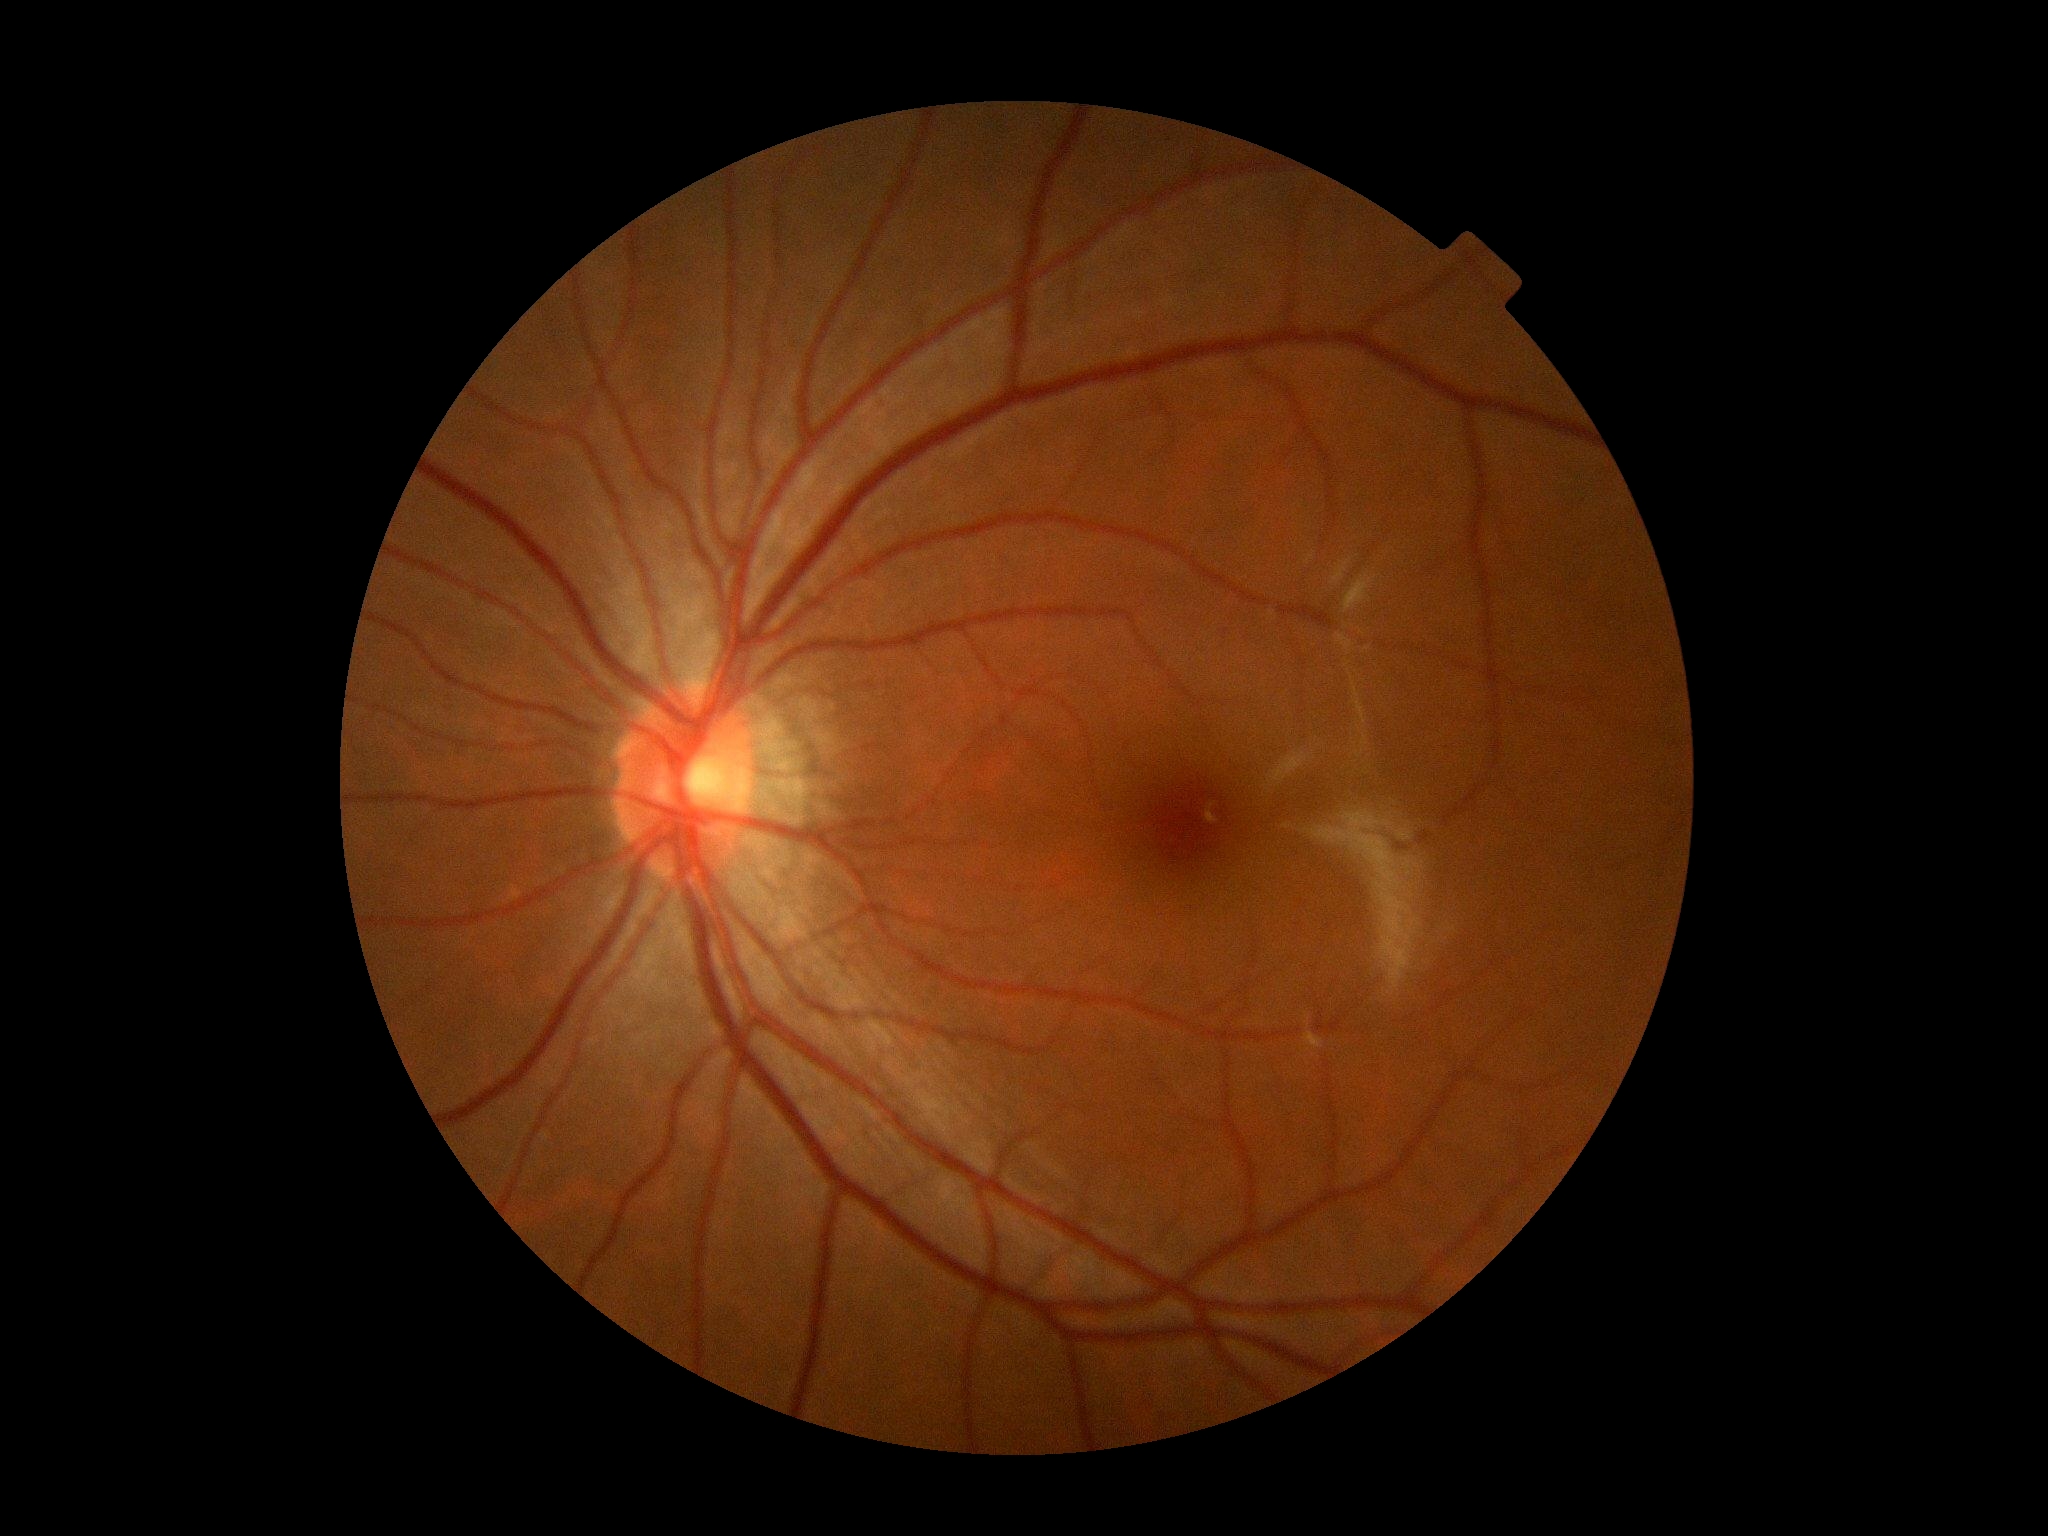

– retinopathy: 0
– DR impression: no apparent DR